Color fundus image: 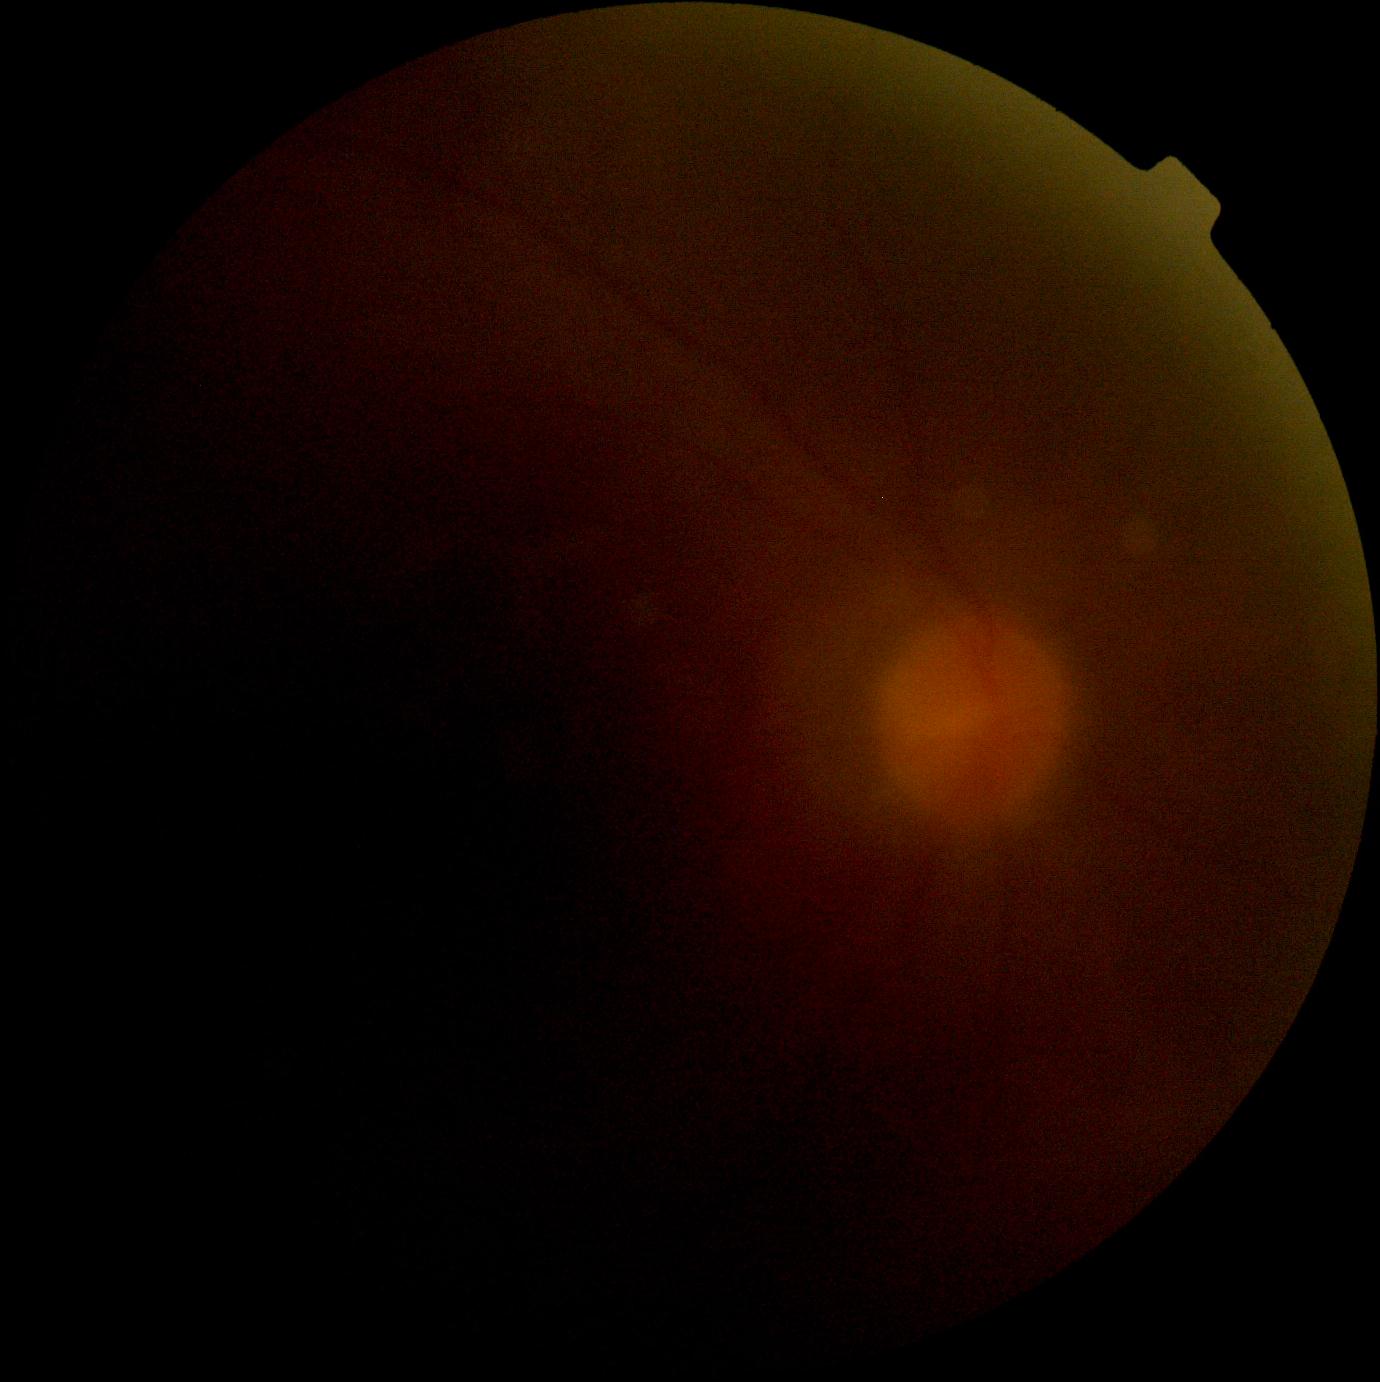
Diabetic retinopathy grade is ungradable due to poor image quality.